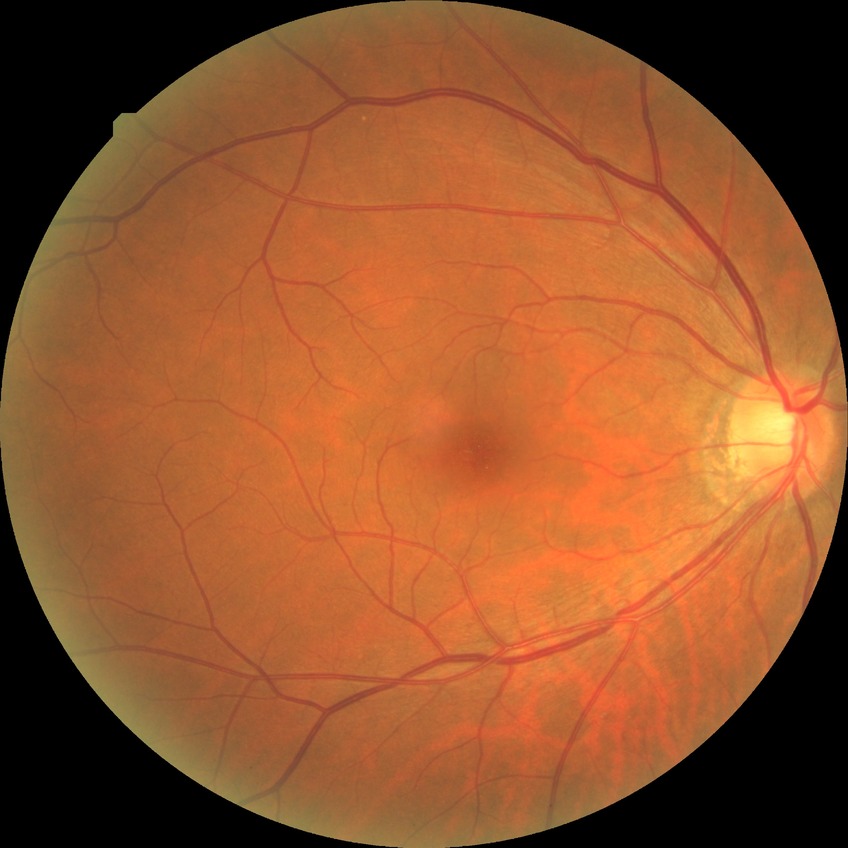
DR grade=NDR.